NIDEK AFC-230: 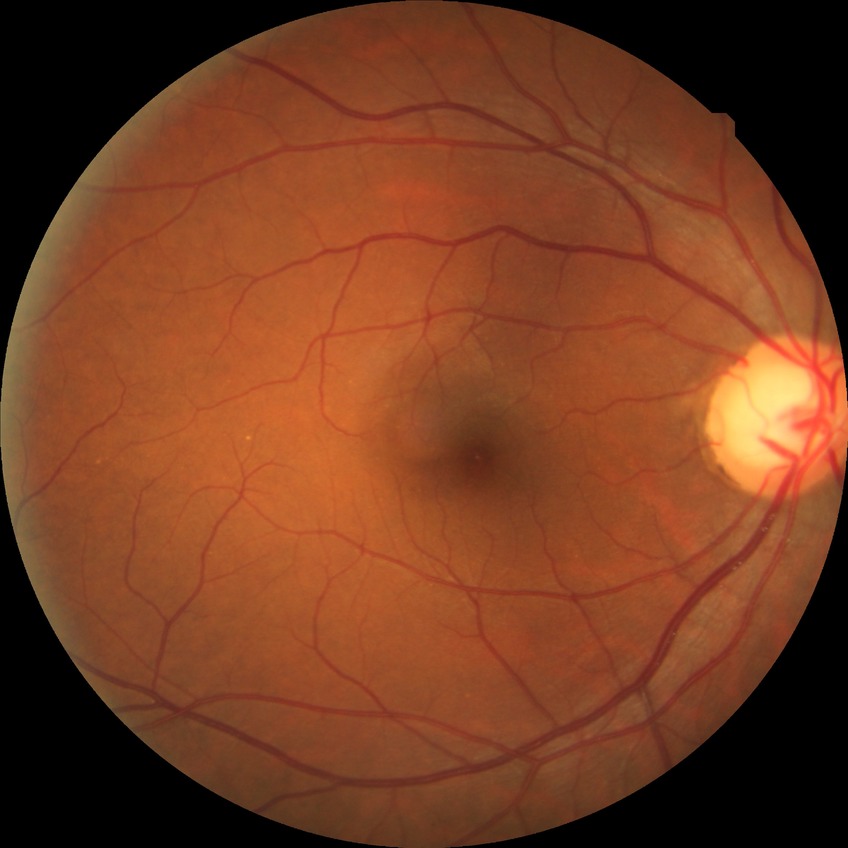 modified Davis grade = NDR, DR impression = no DR findings.